Image size 1440x1080 · wide-field contact fundus photograph of an infant
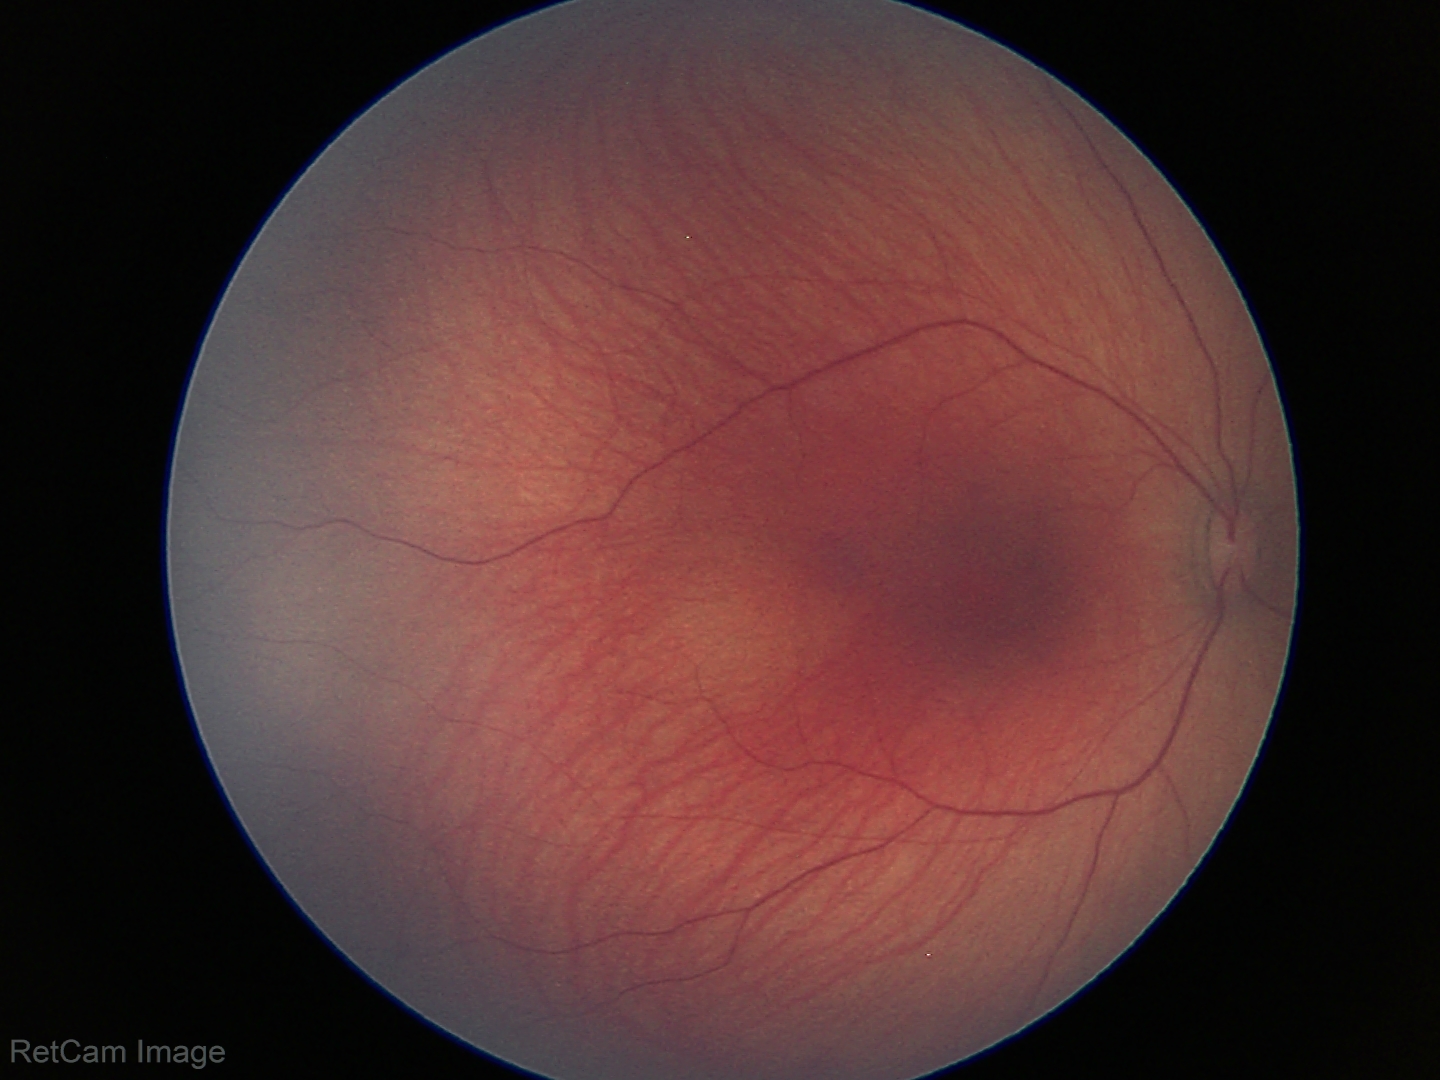

Physiological retinal appearance for postconceptual age.